Portable fundus camera image: 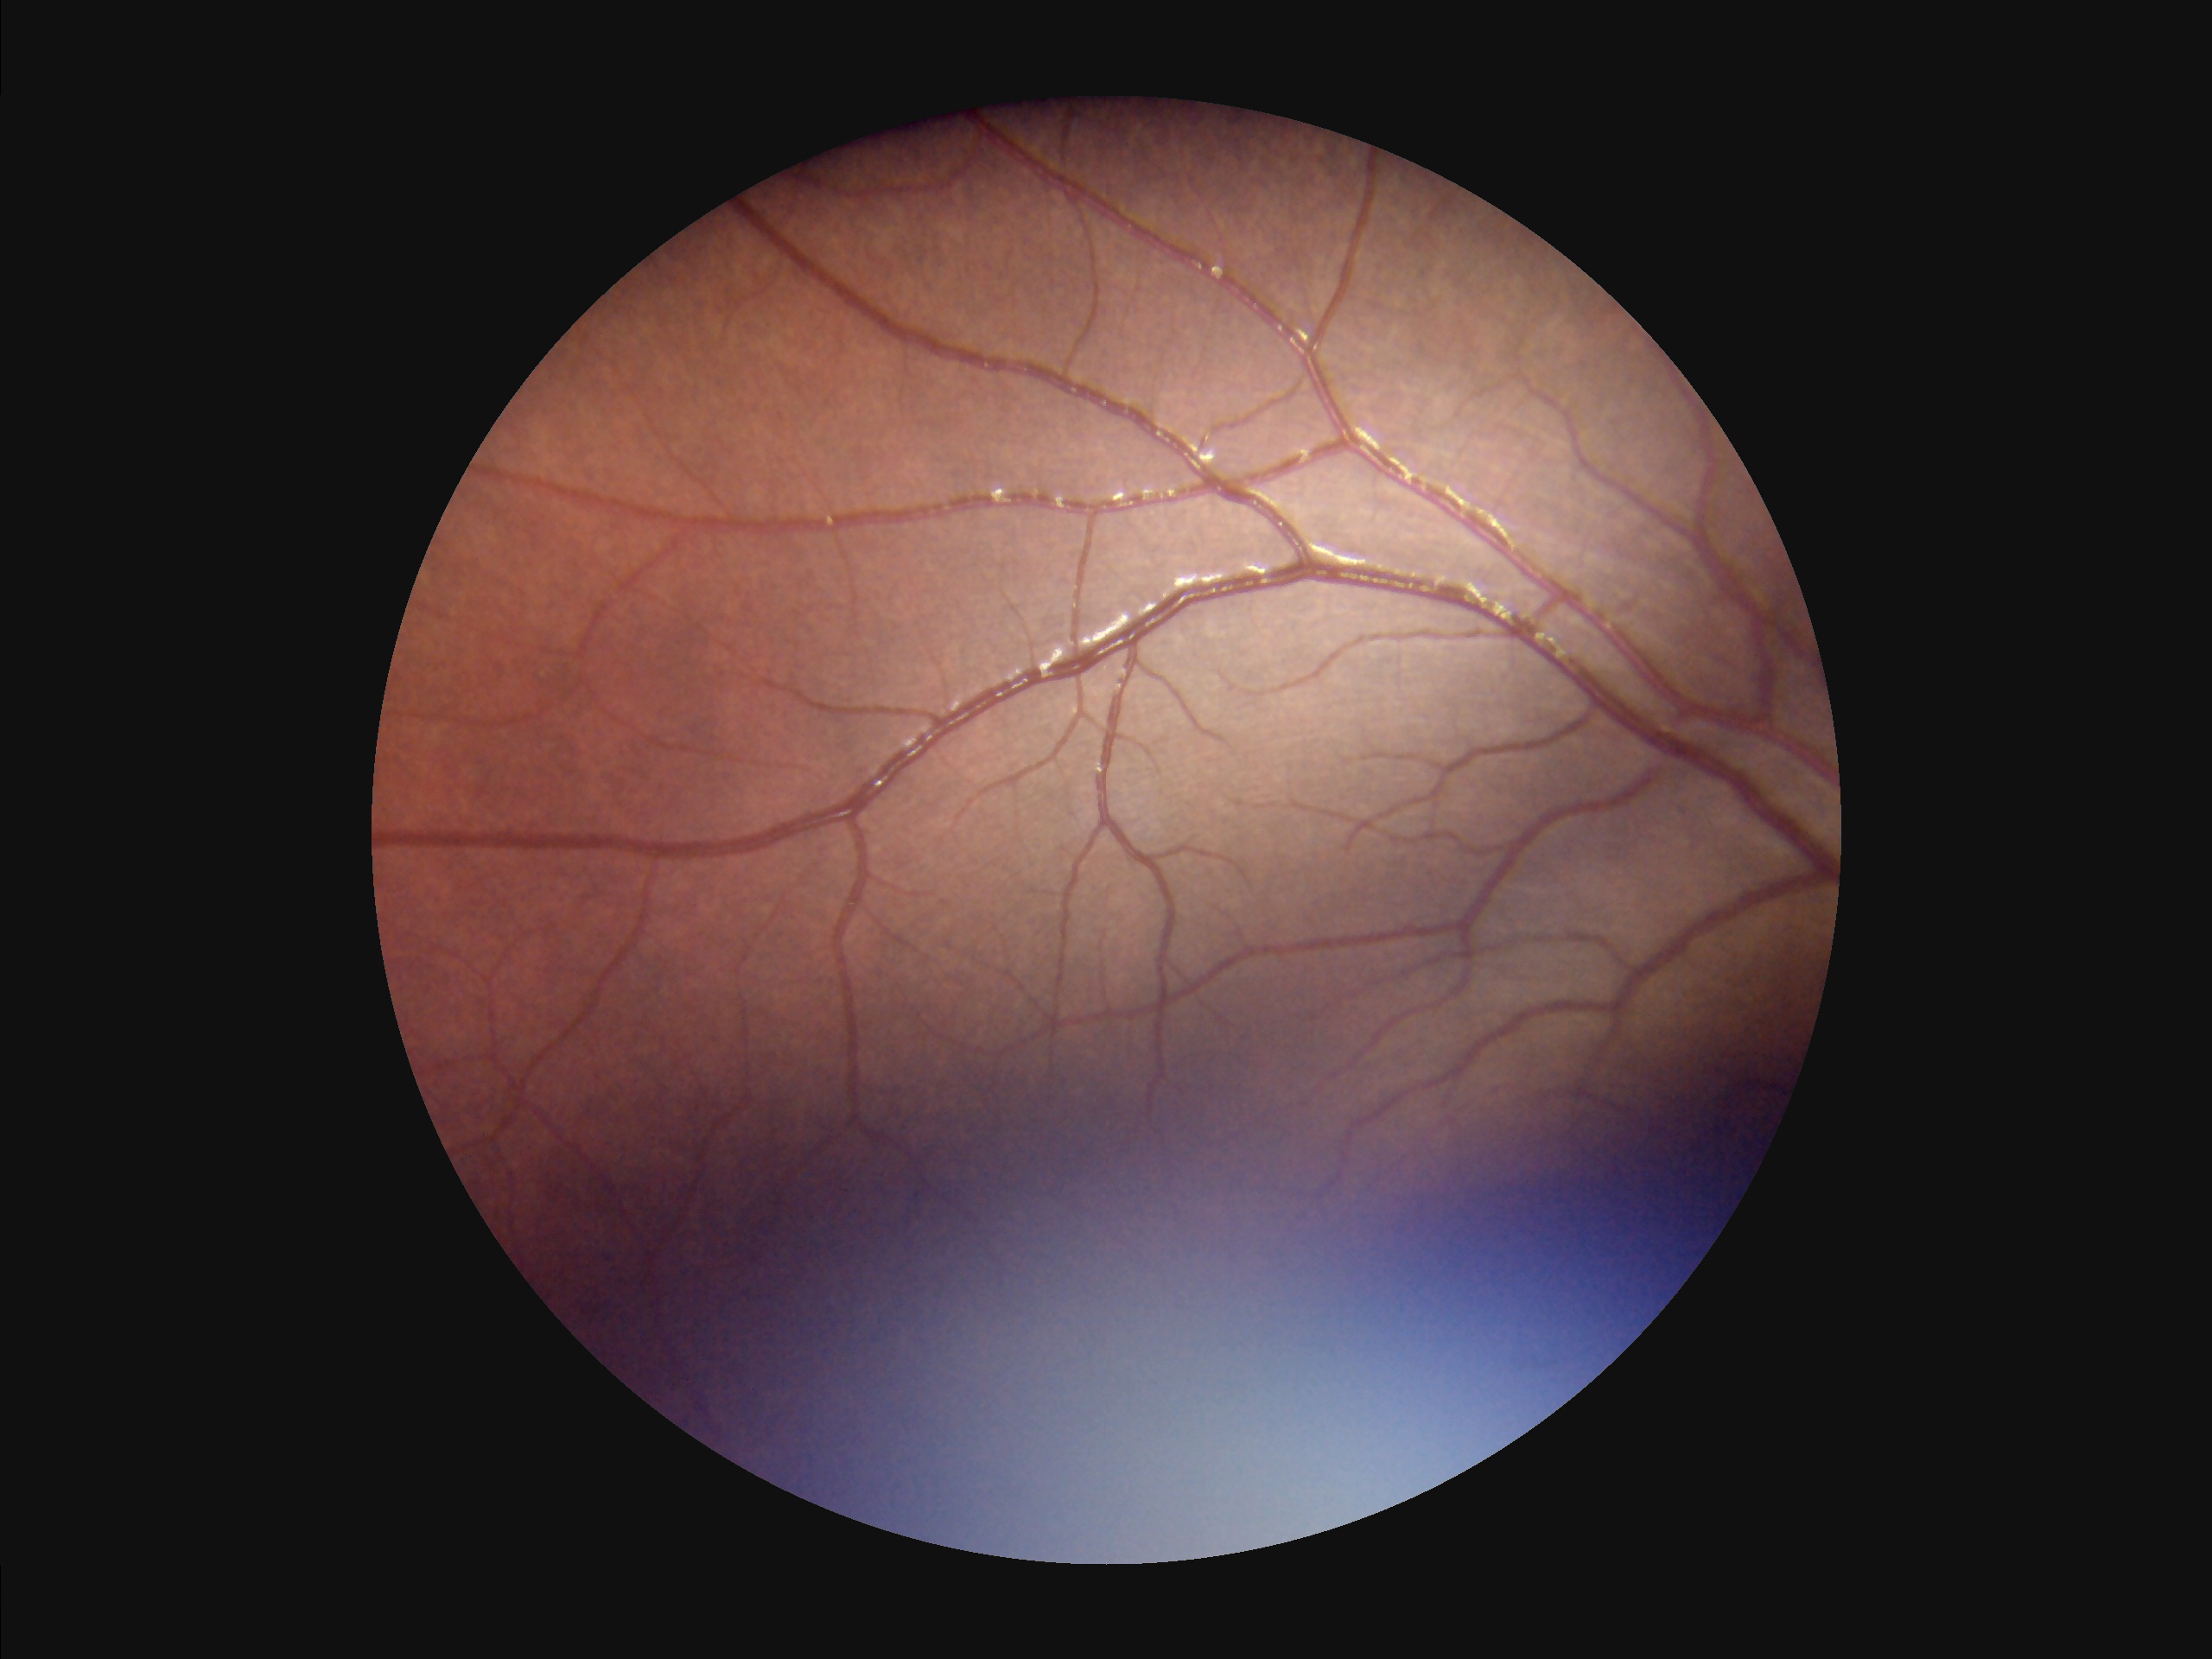

Contrast = adequate; Illumination/color = poor; Focus = out of focus; Overall quality = inadequate.